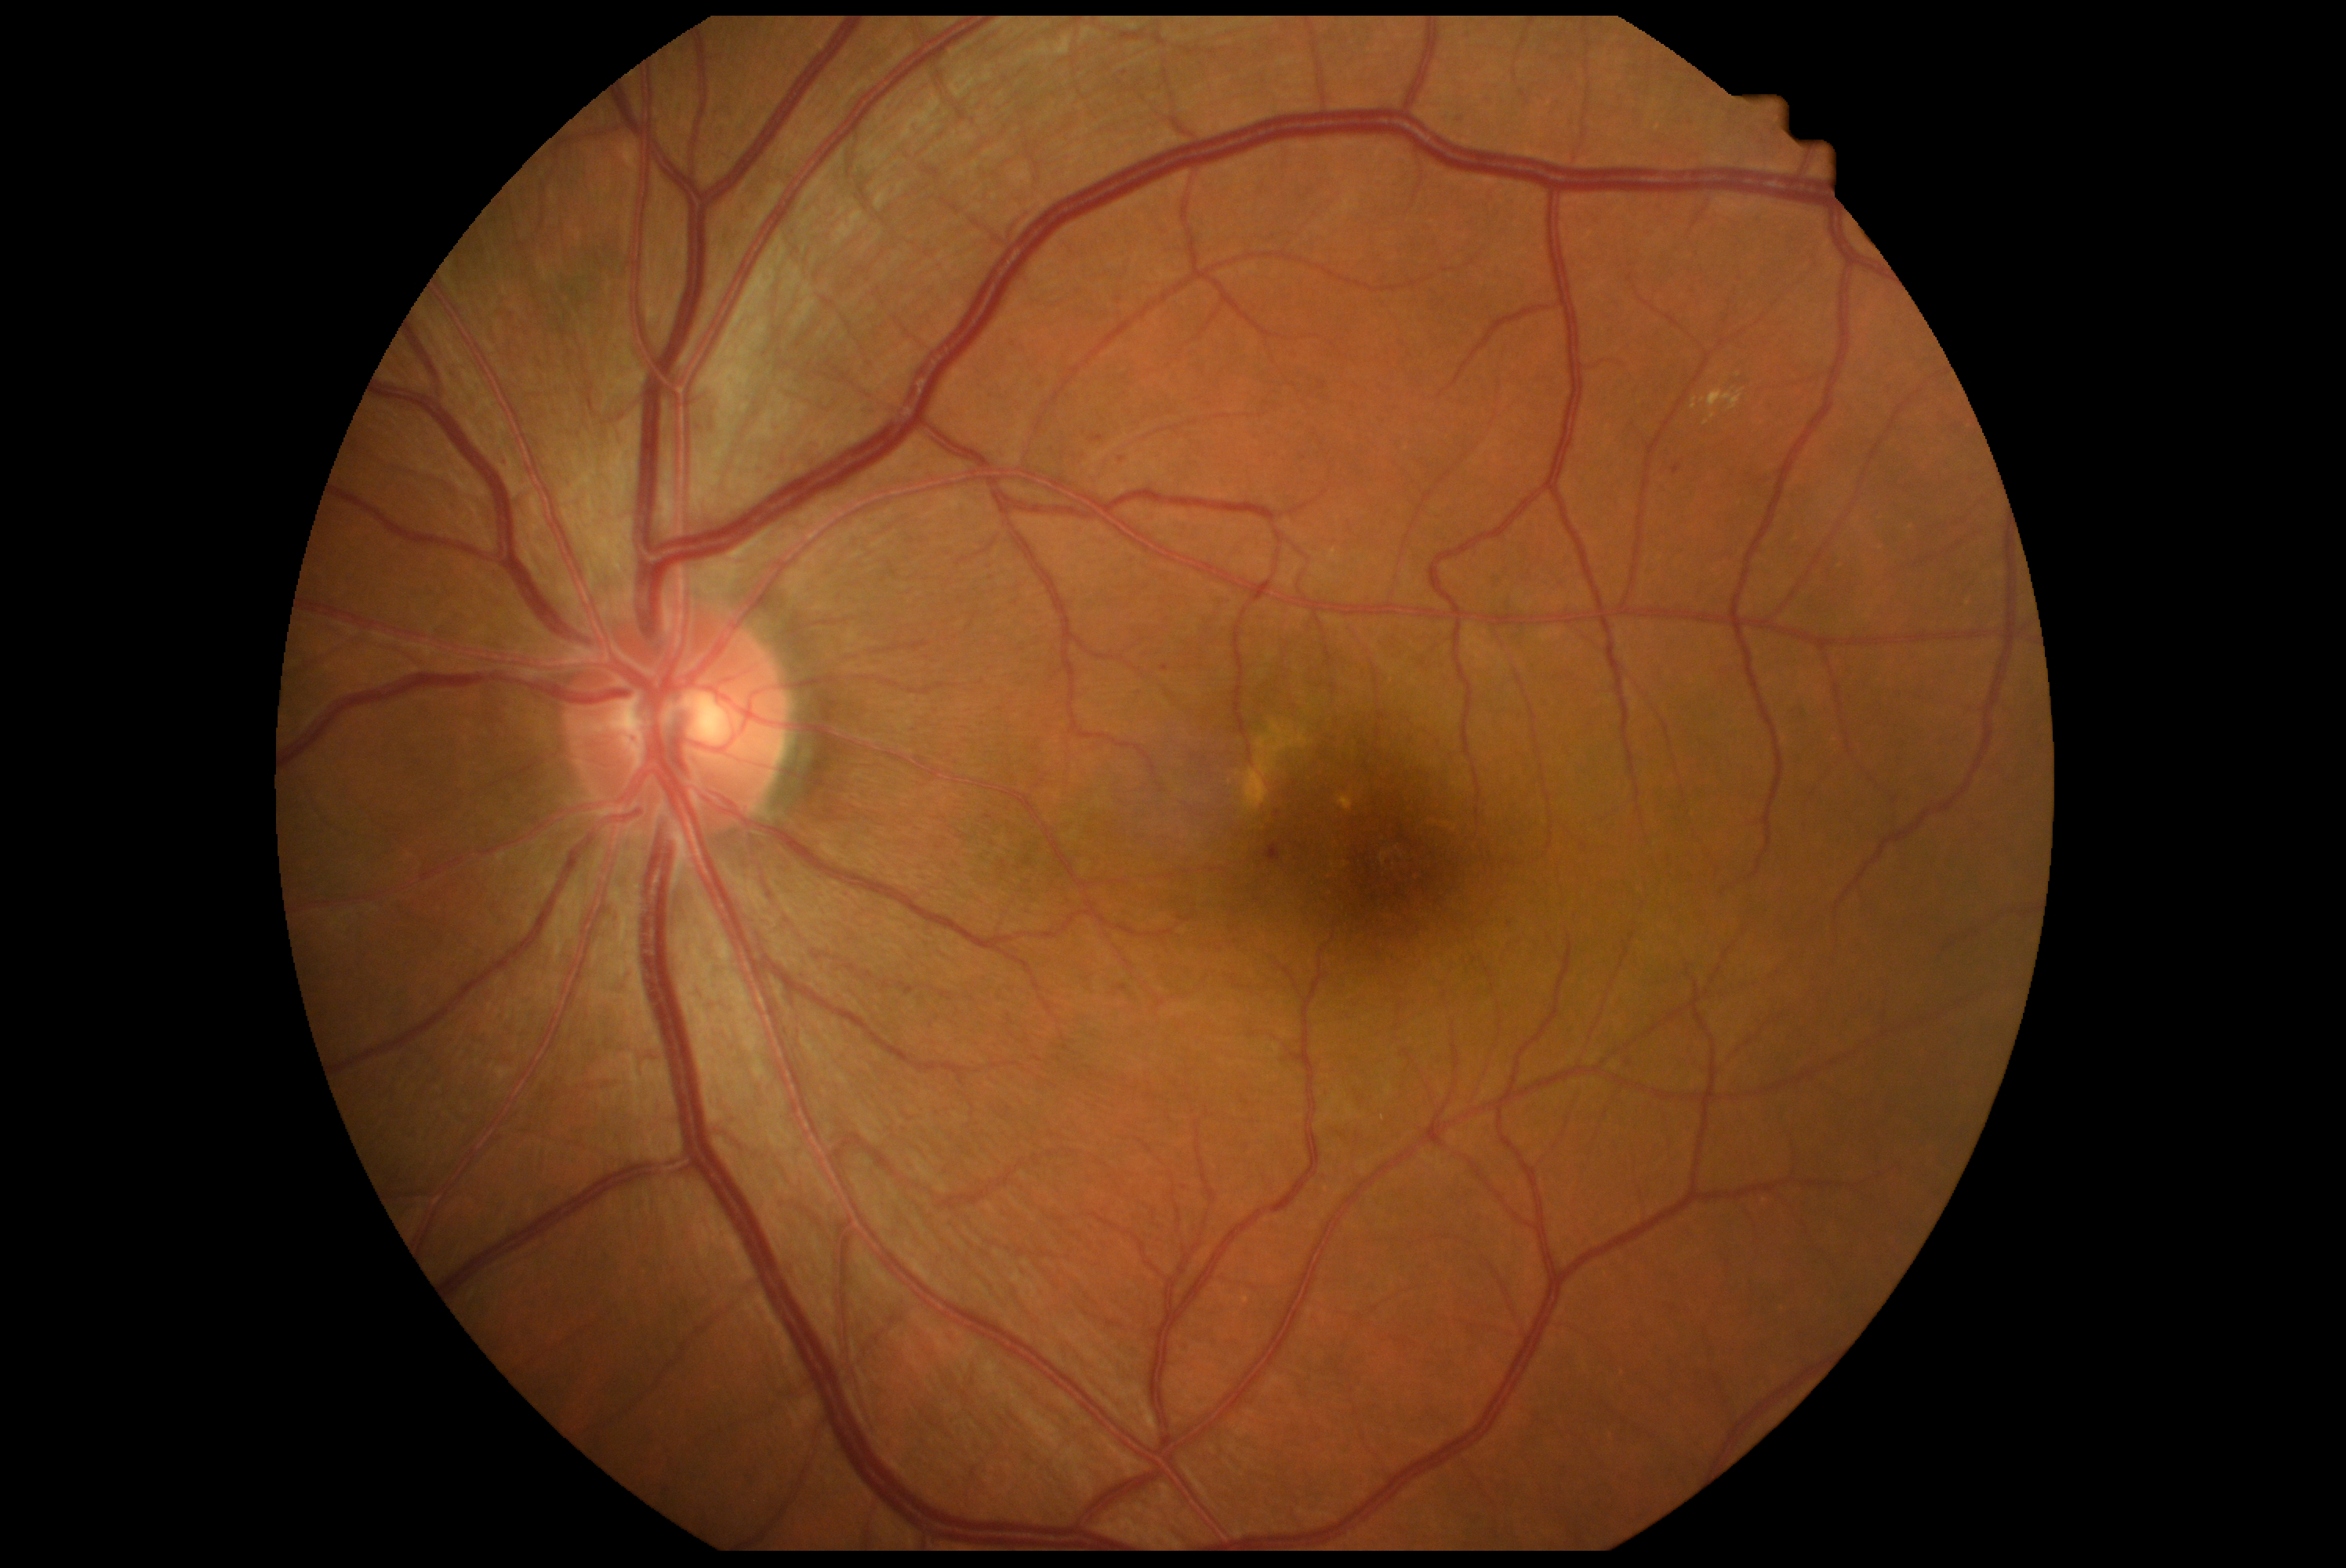
DR severity: 2/4. The retinopathy is classified as non-proliferative diabetic retinopathy.